Wide-field contact fundus photograph of an infant; camera: Clarity RetCam 3 (130° FOV); 640 x 480 pixels: 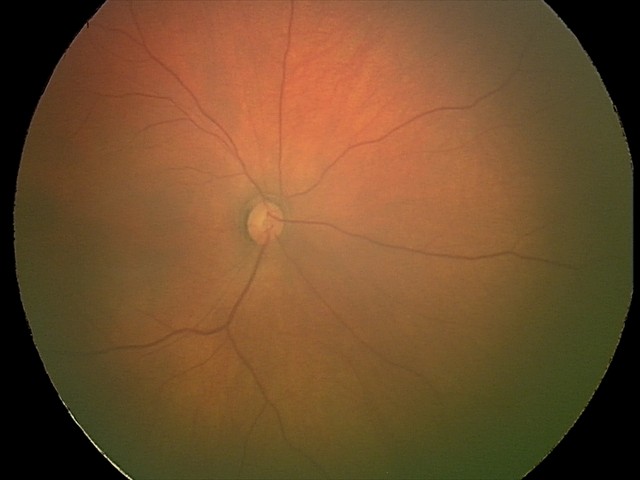
Screening examination with no abnormal retinal findings.